1240x1240px. Captured with the Phoenix ICON (100° field of view). Infant wide-field fundus photograph: 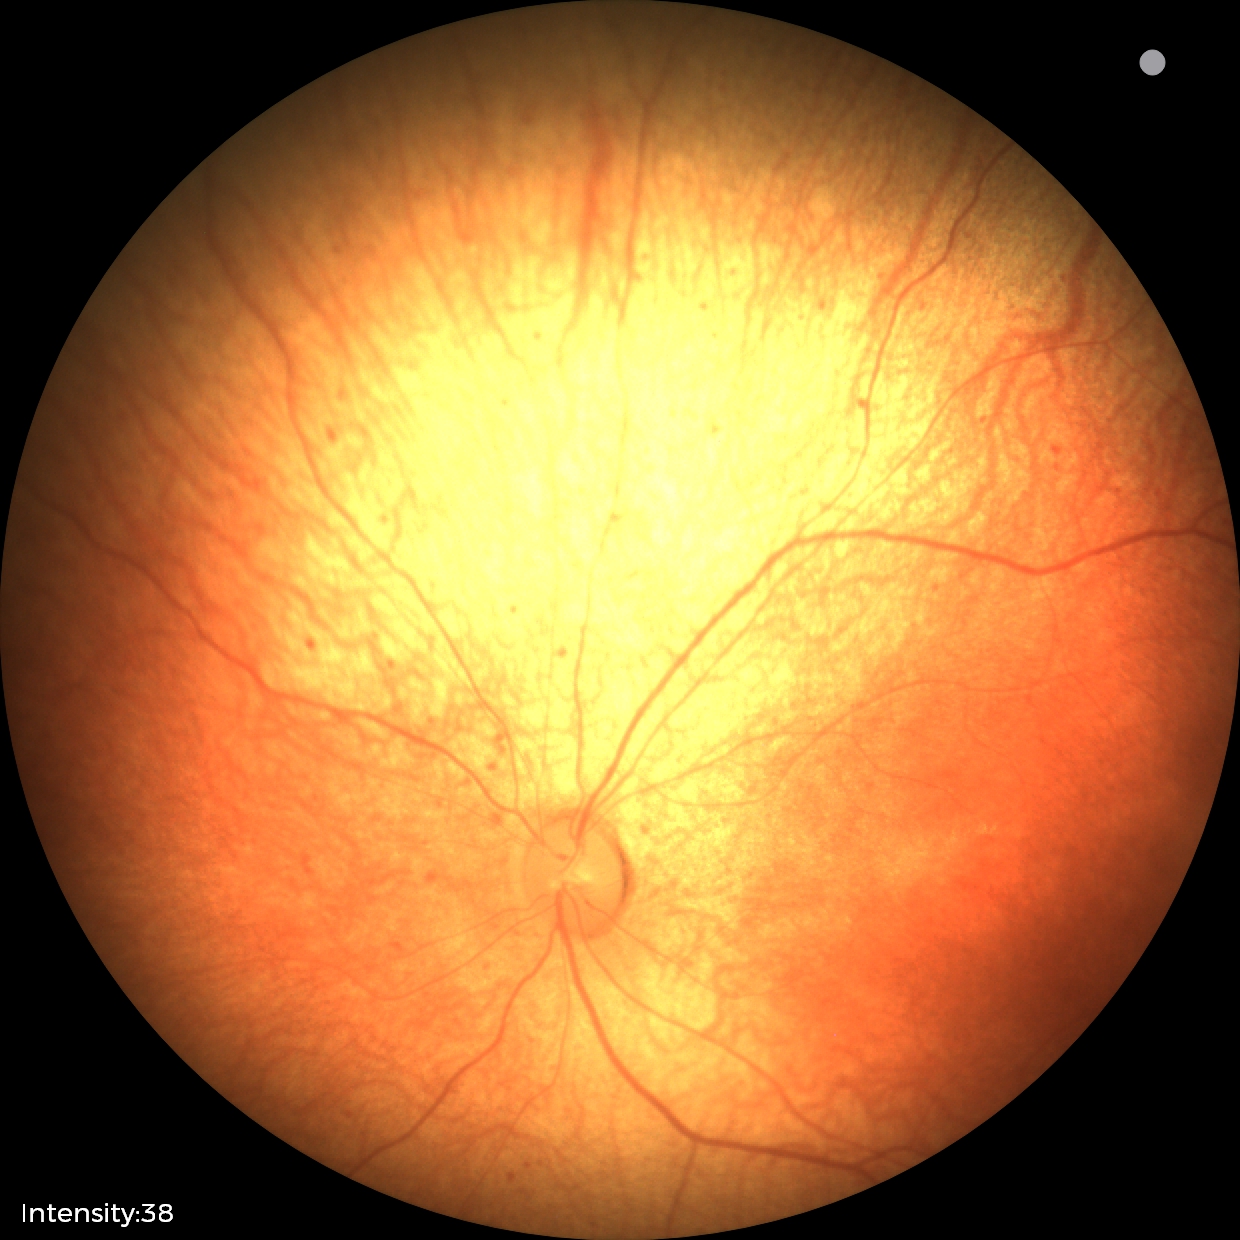
Examination diagnosed as status post retinopathy of prematurity (ROP). No plus disease.